Wide-field fundus photograph from neonatal ROP screening: 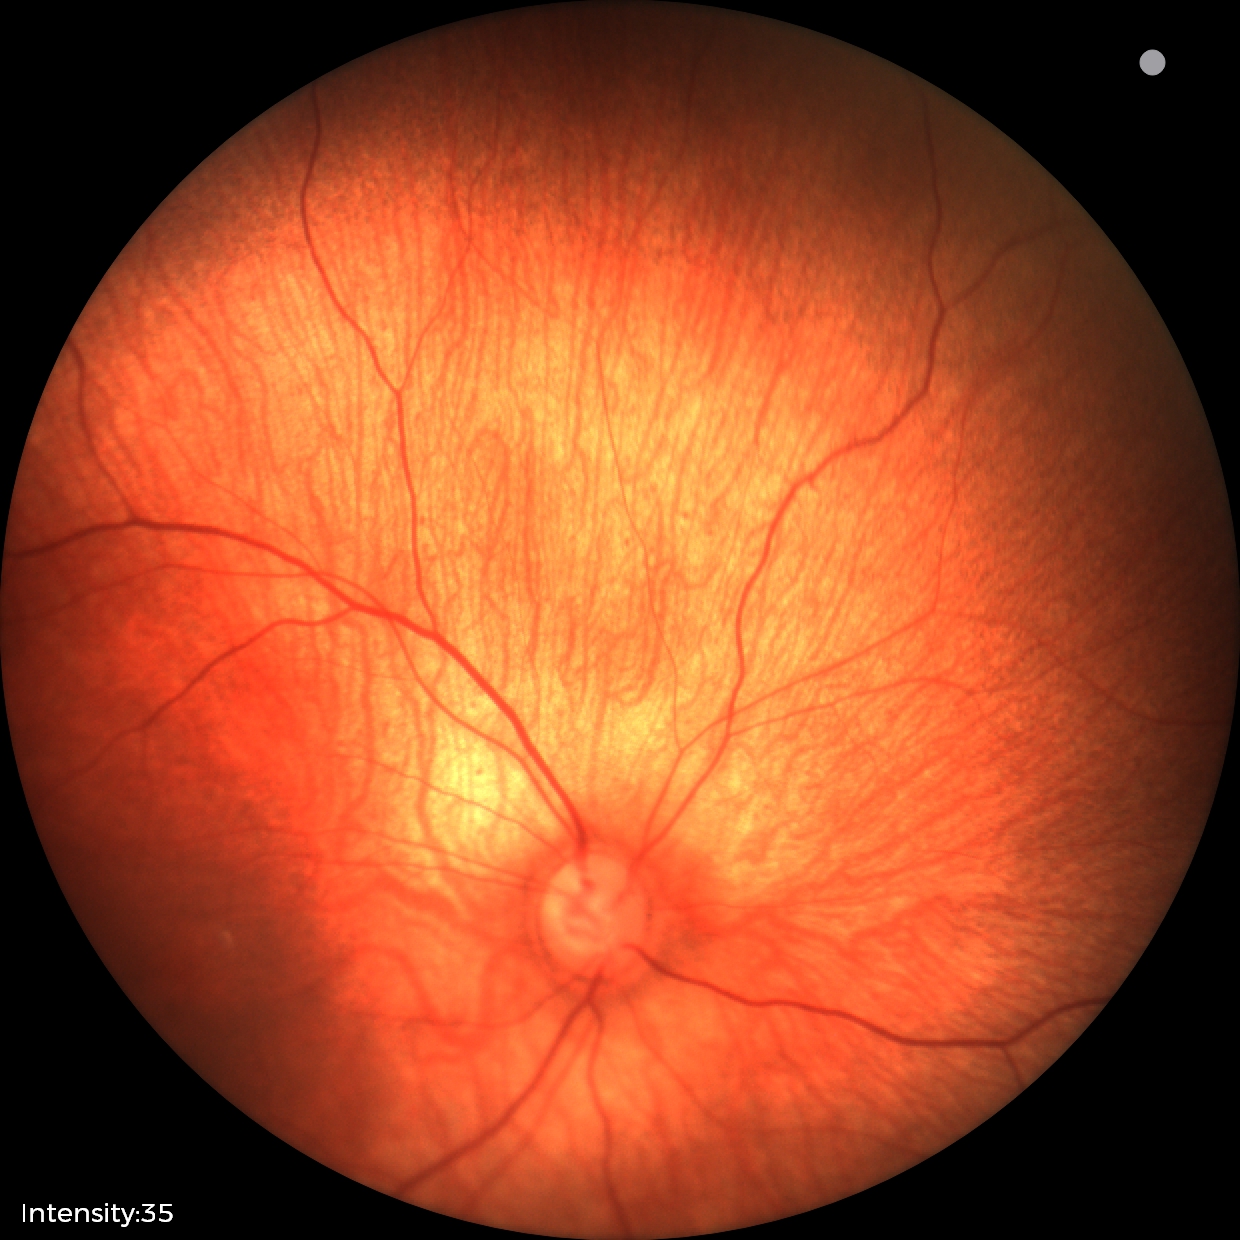
Screening examination with no abnormal retinal findings.